Captured on a Topcon TRC-NW8 fundus camera. 1932x1932. 50° field of view — 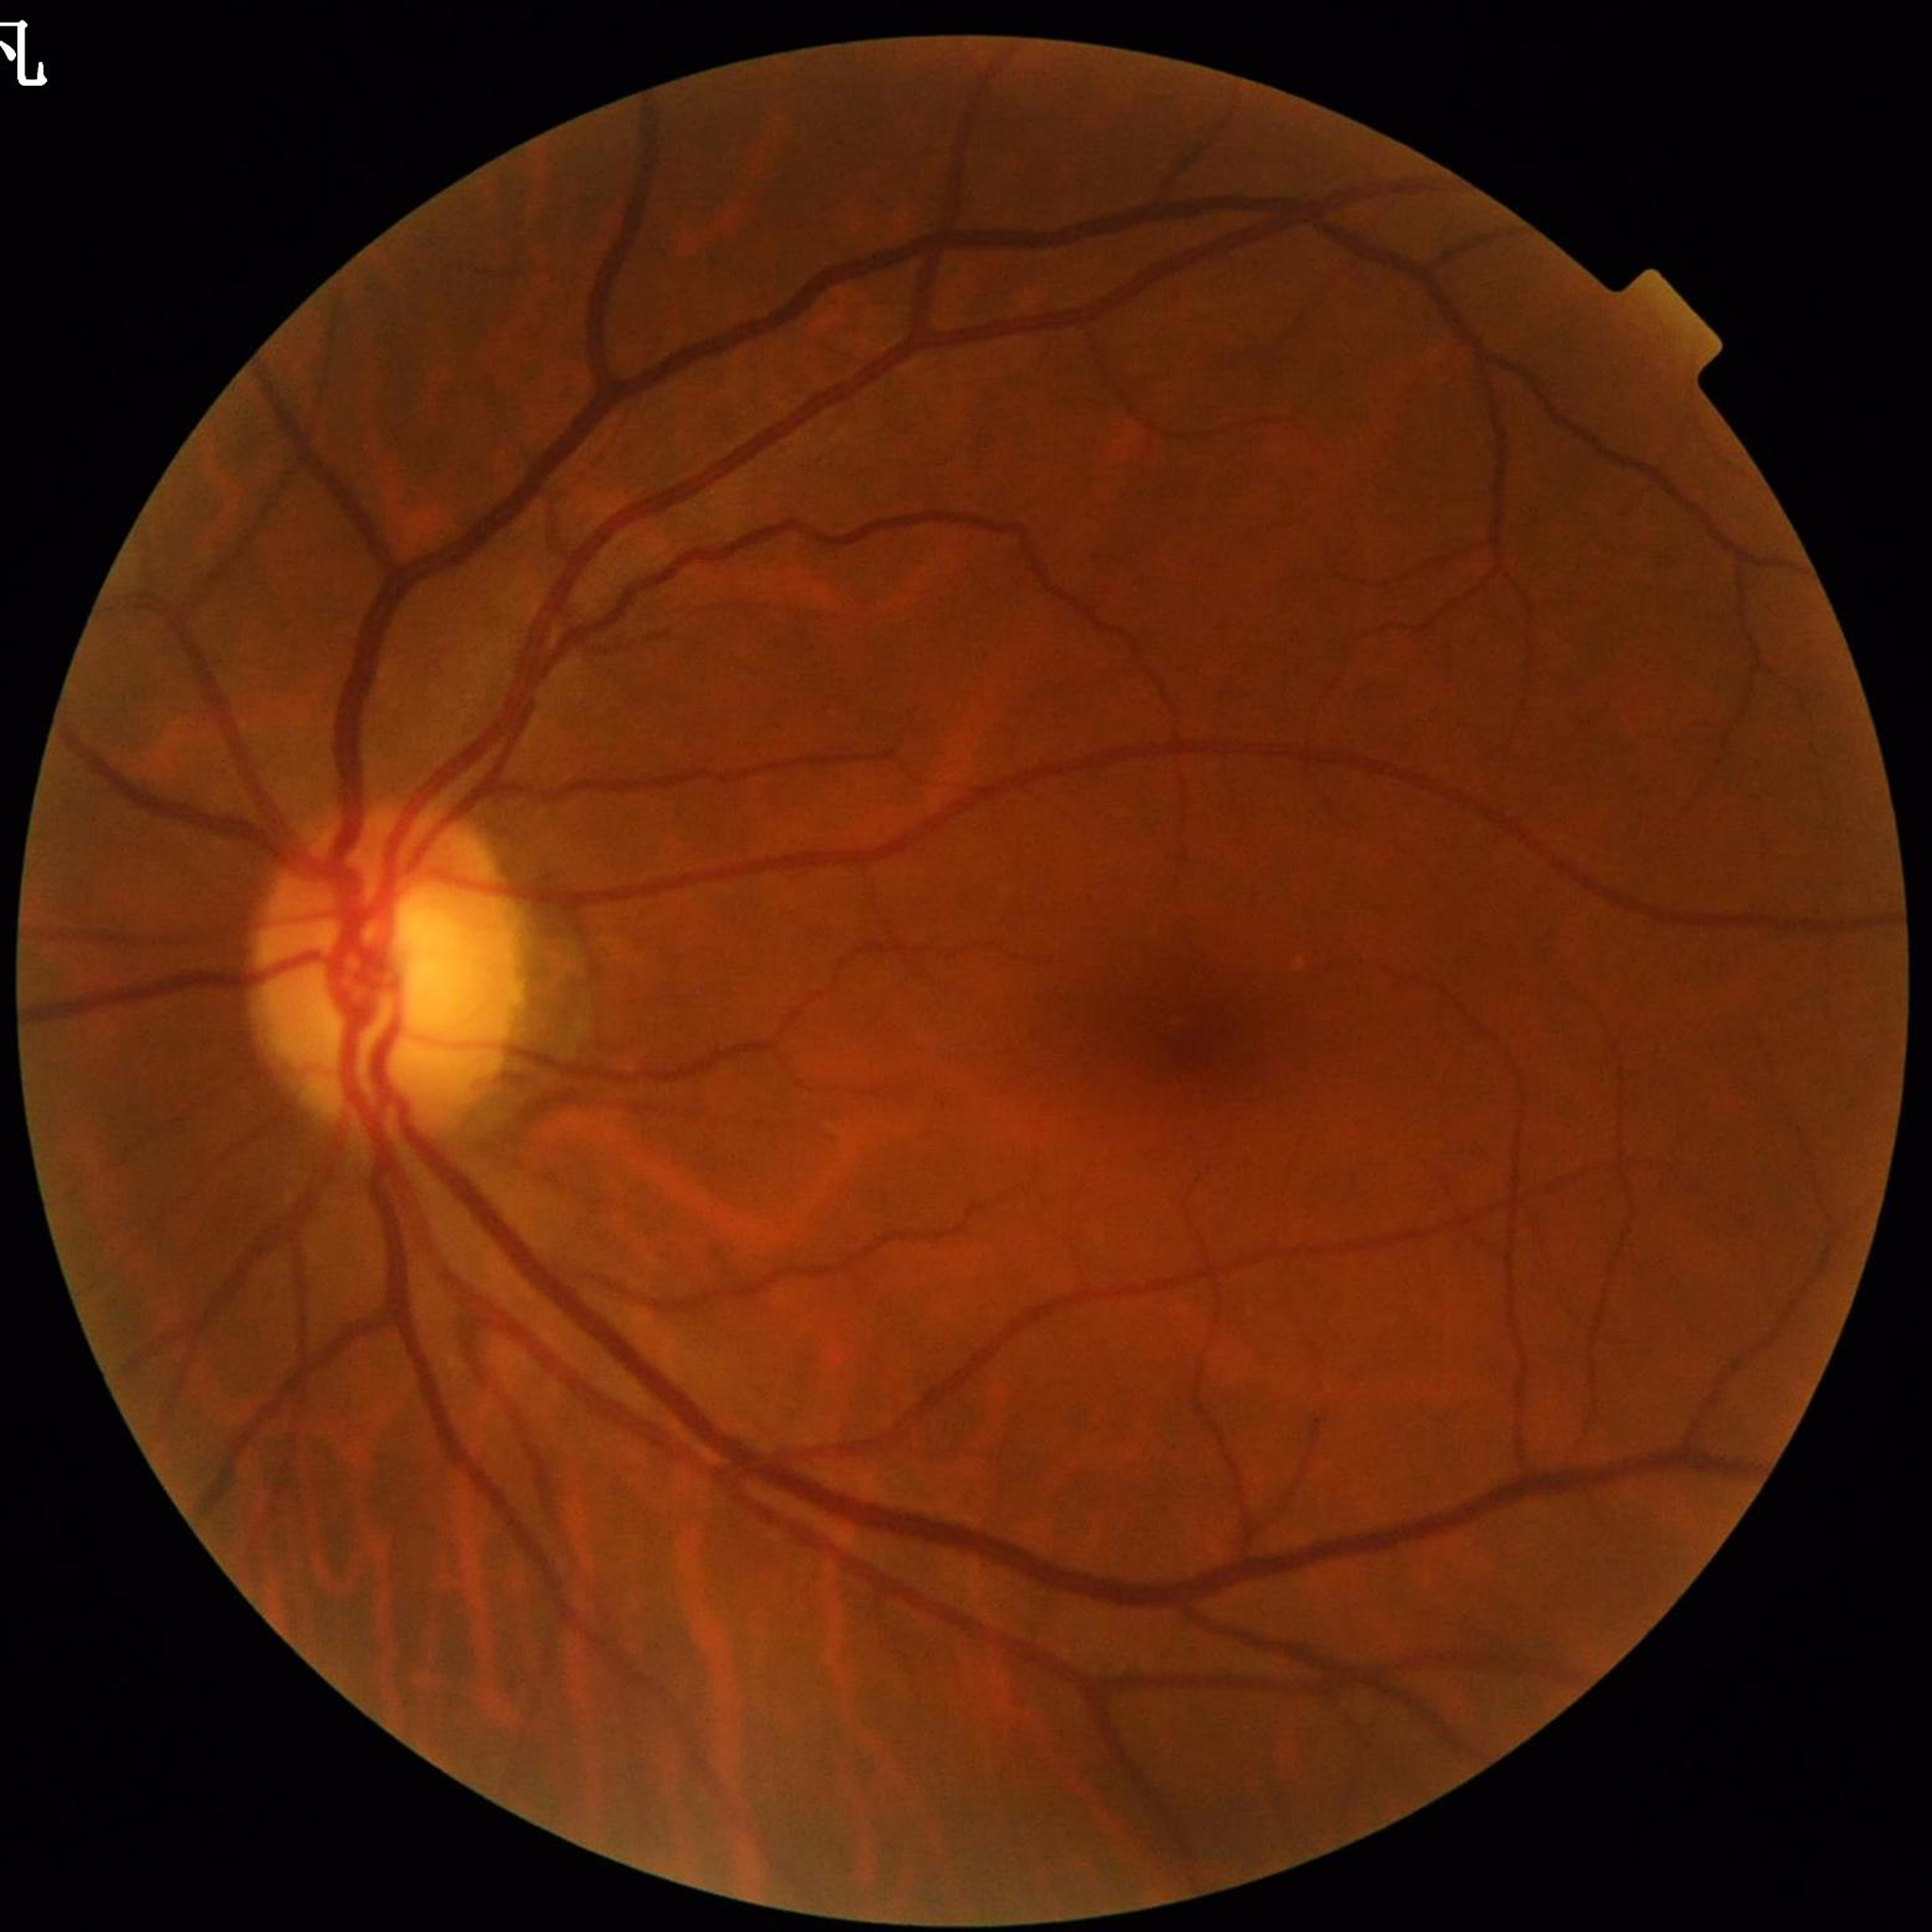
Disease: diabetic retinopathy (DR); Automated quality assessment: no blur, contrast adequate, illumination and color satisfactory.